RetCam wide-field infant fundus image
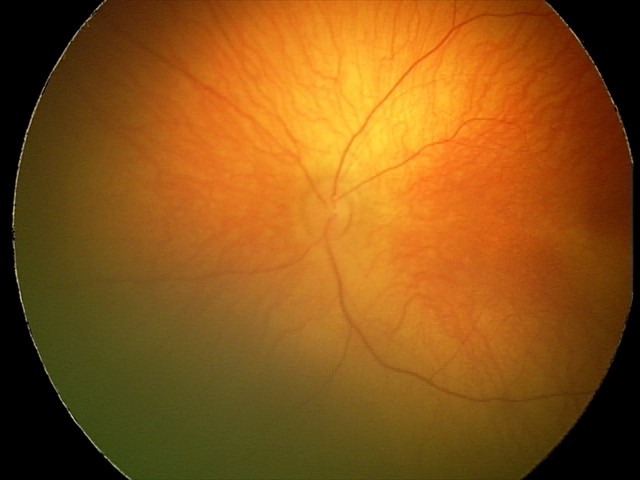

Screening examination consistent with retinal hemorrhages.